Age 69. Non-mydriatic
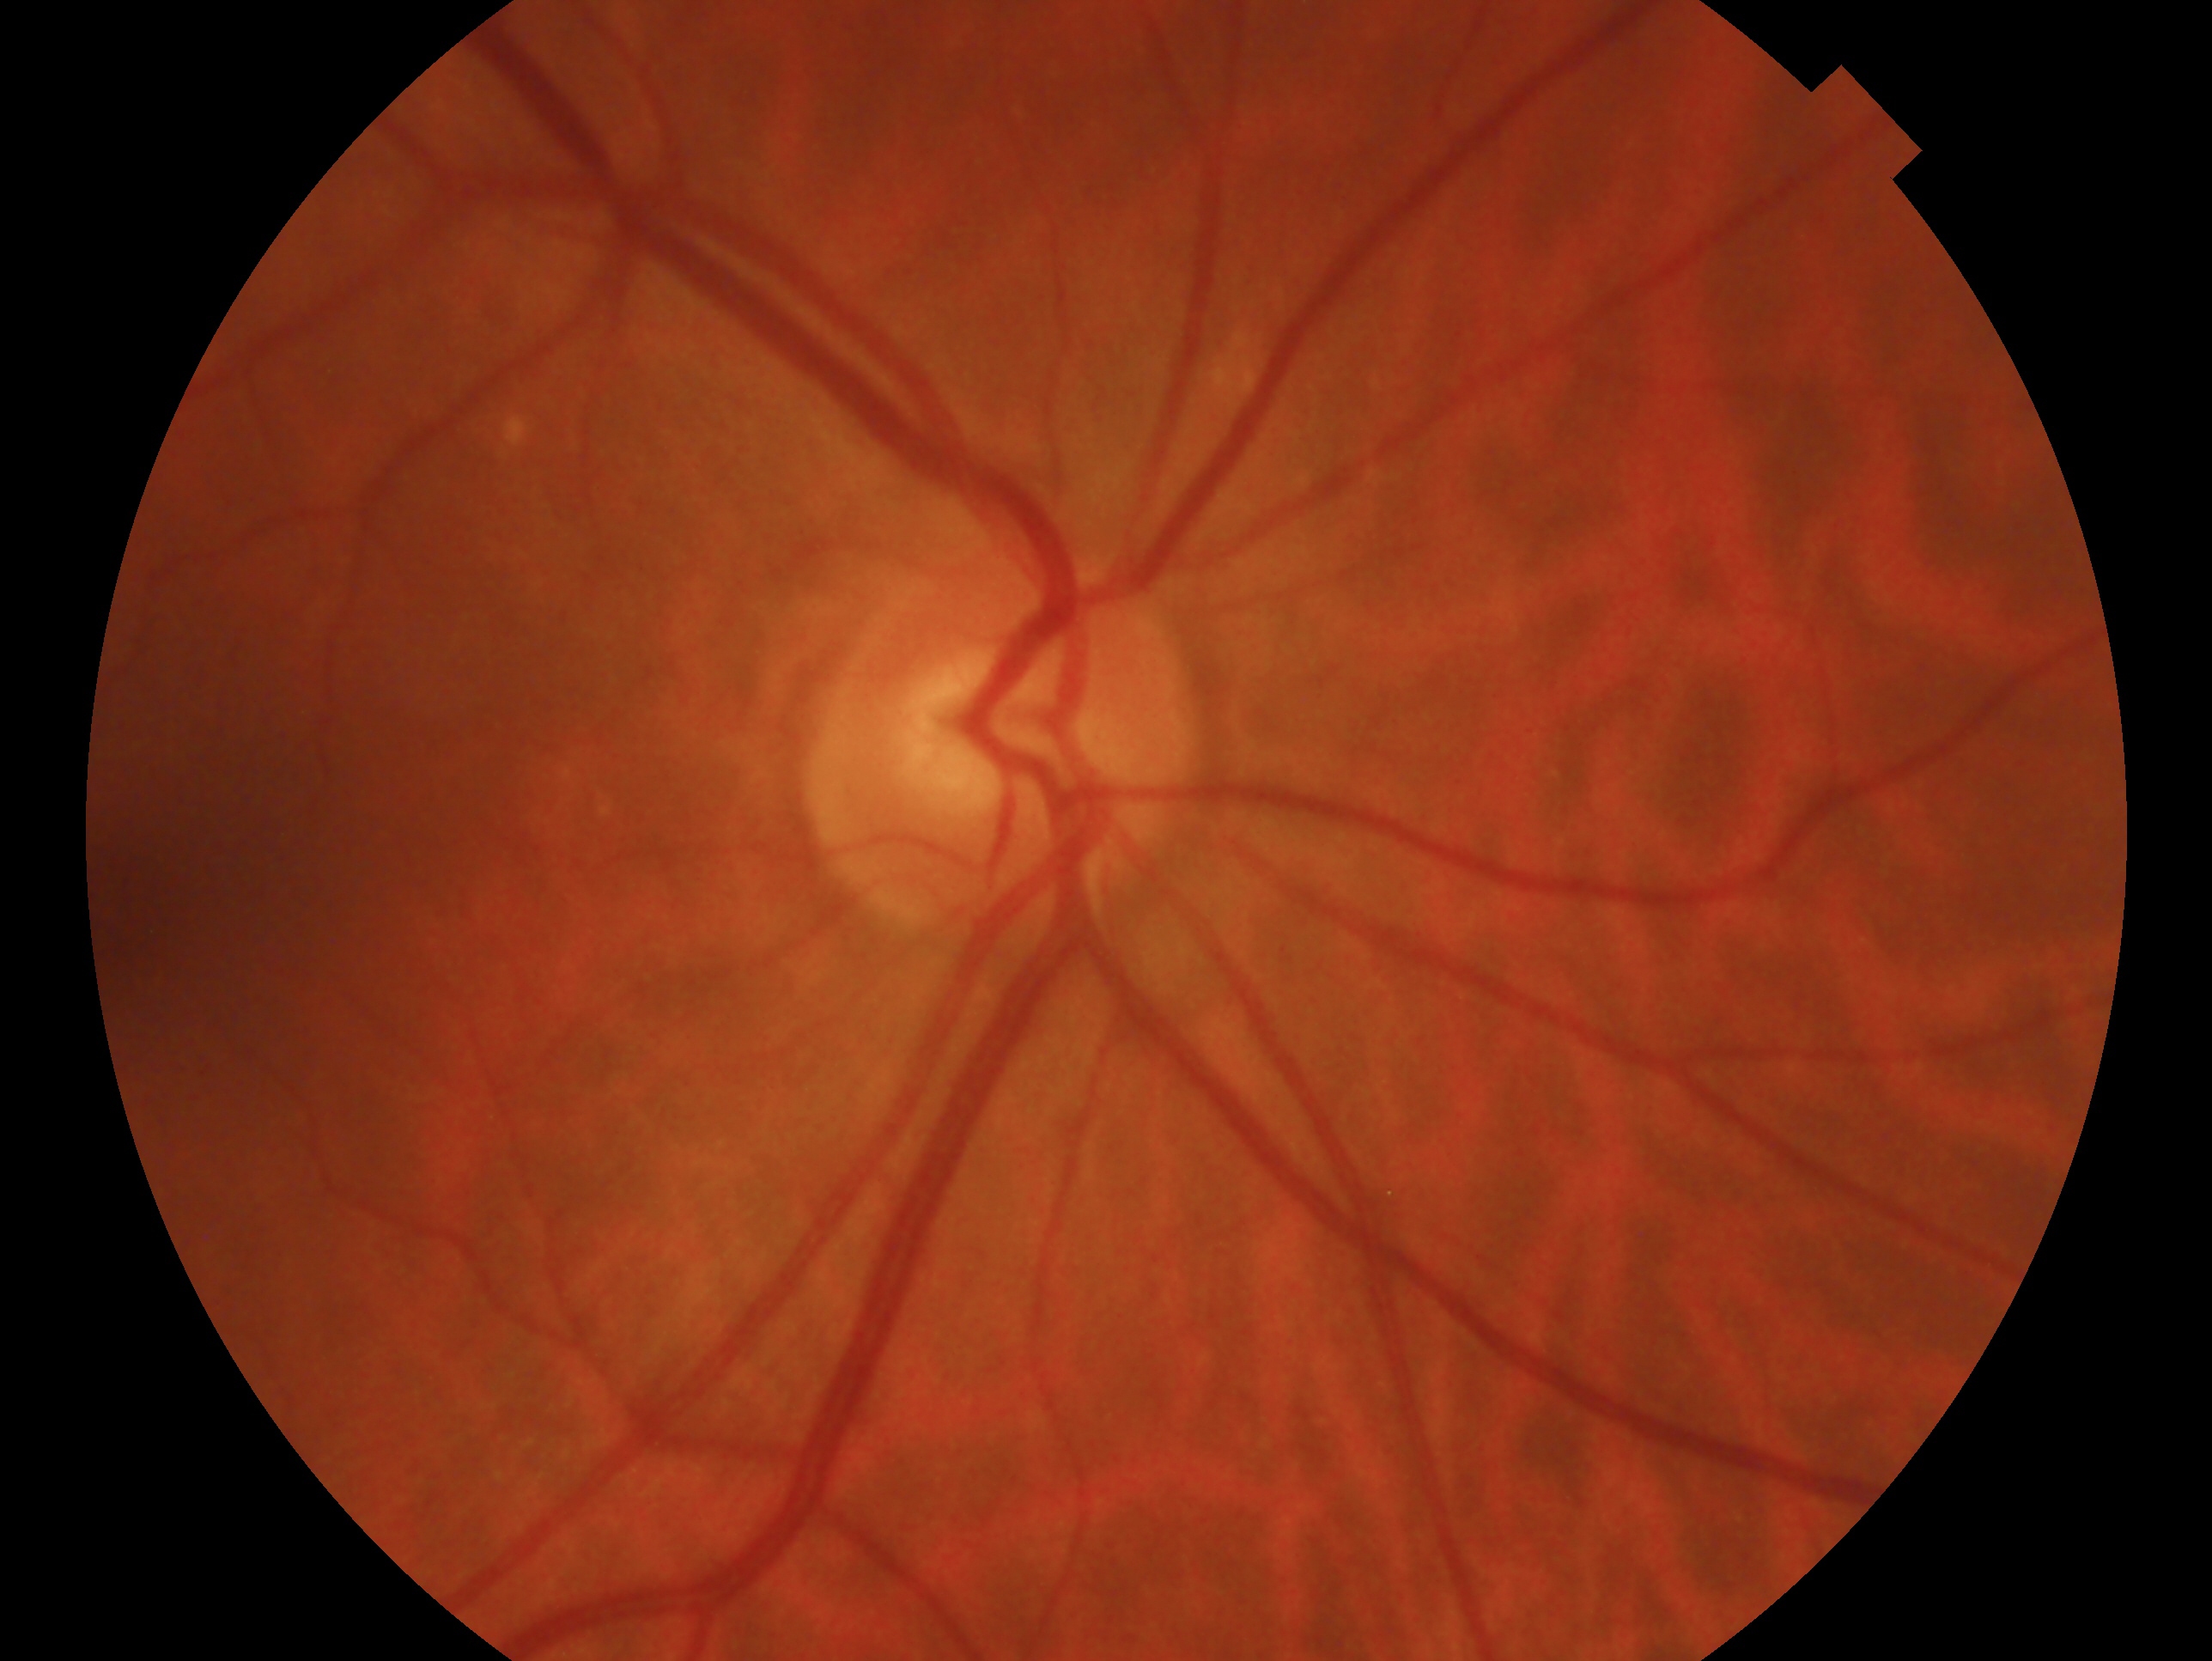 eye: right
glaucoma_dx: no glaucoma